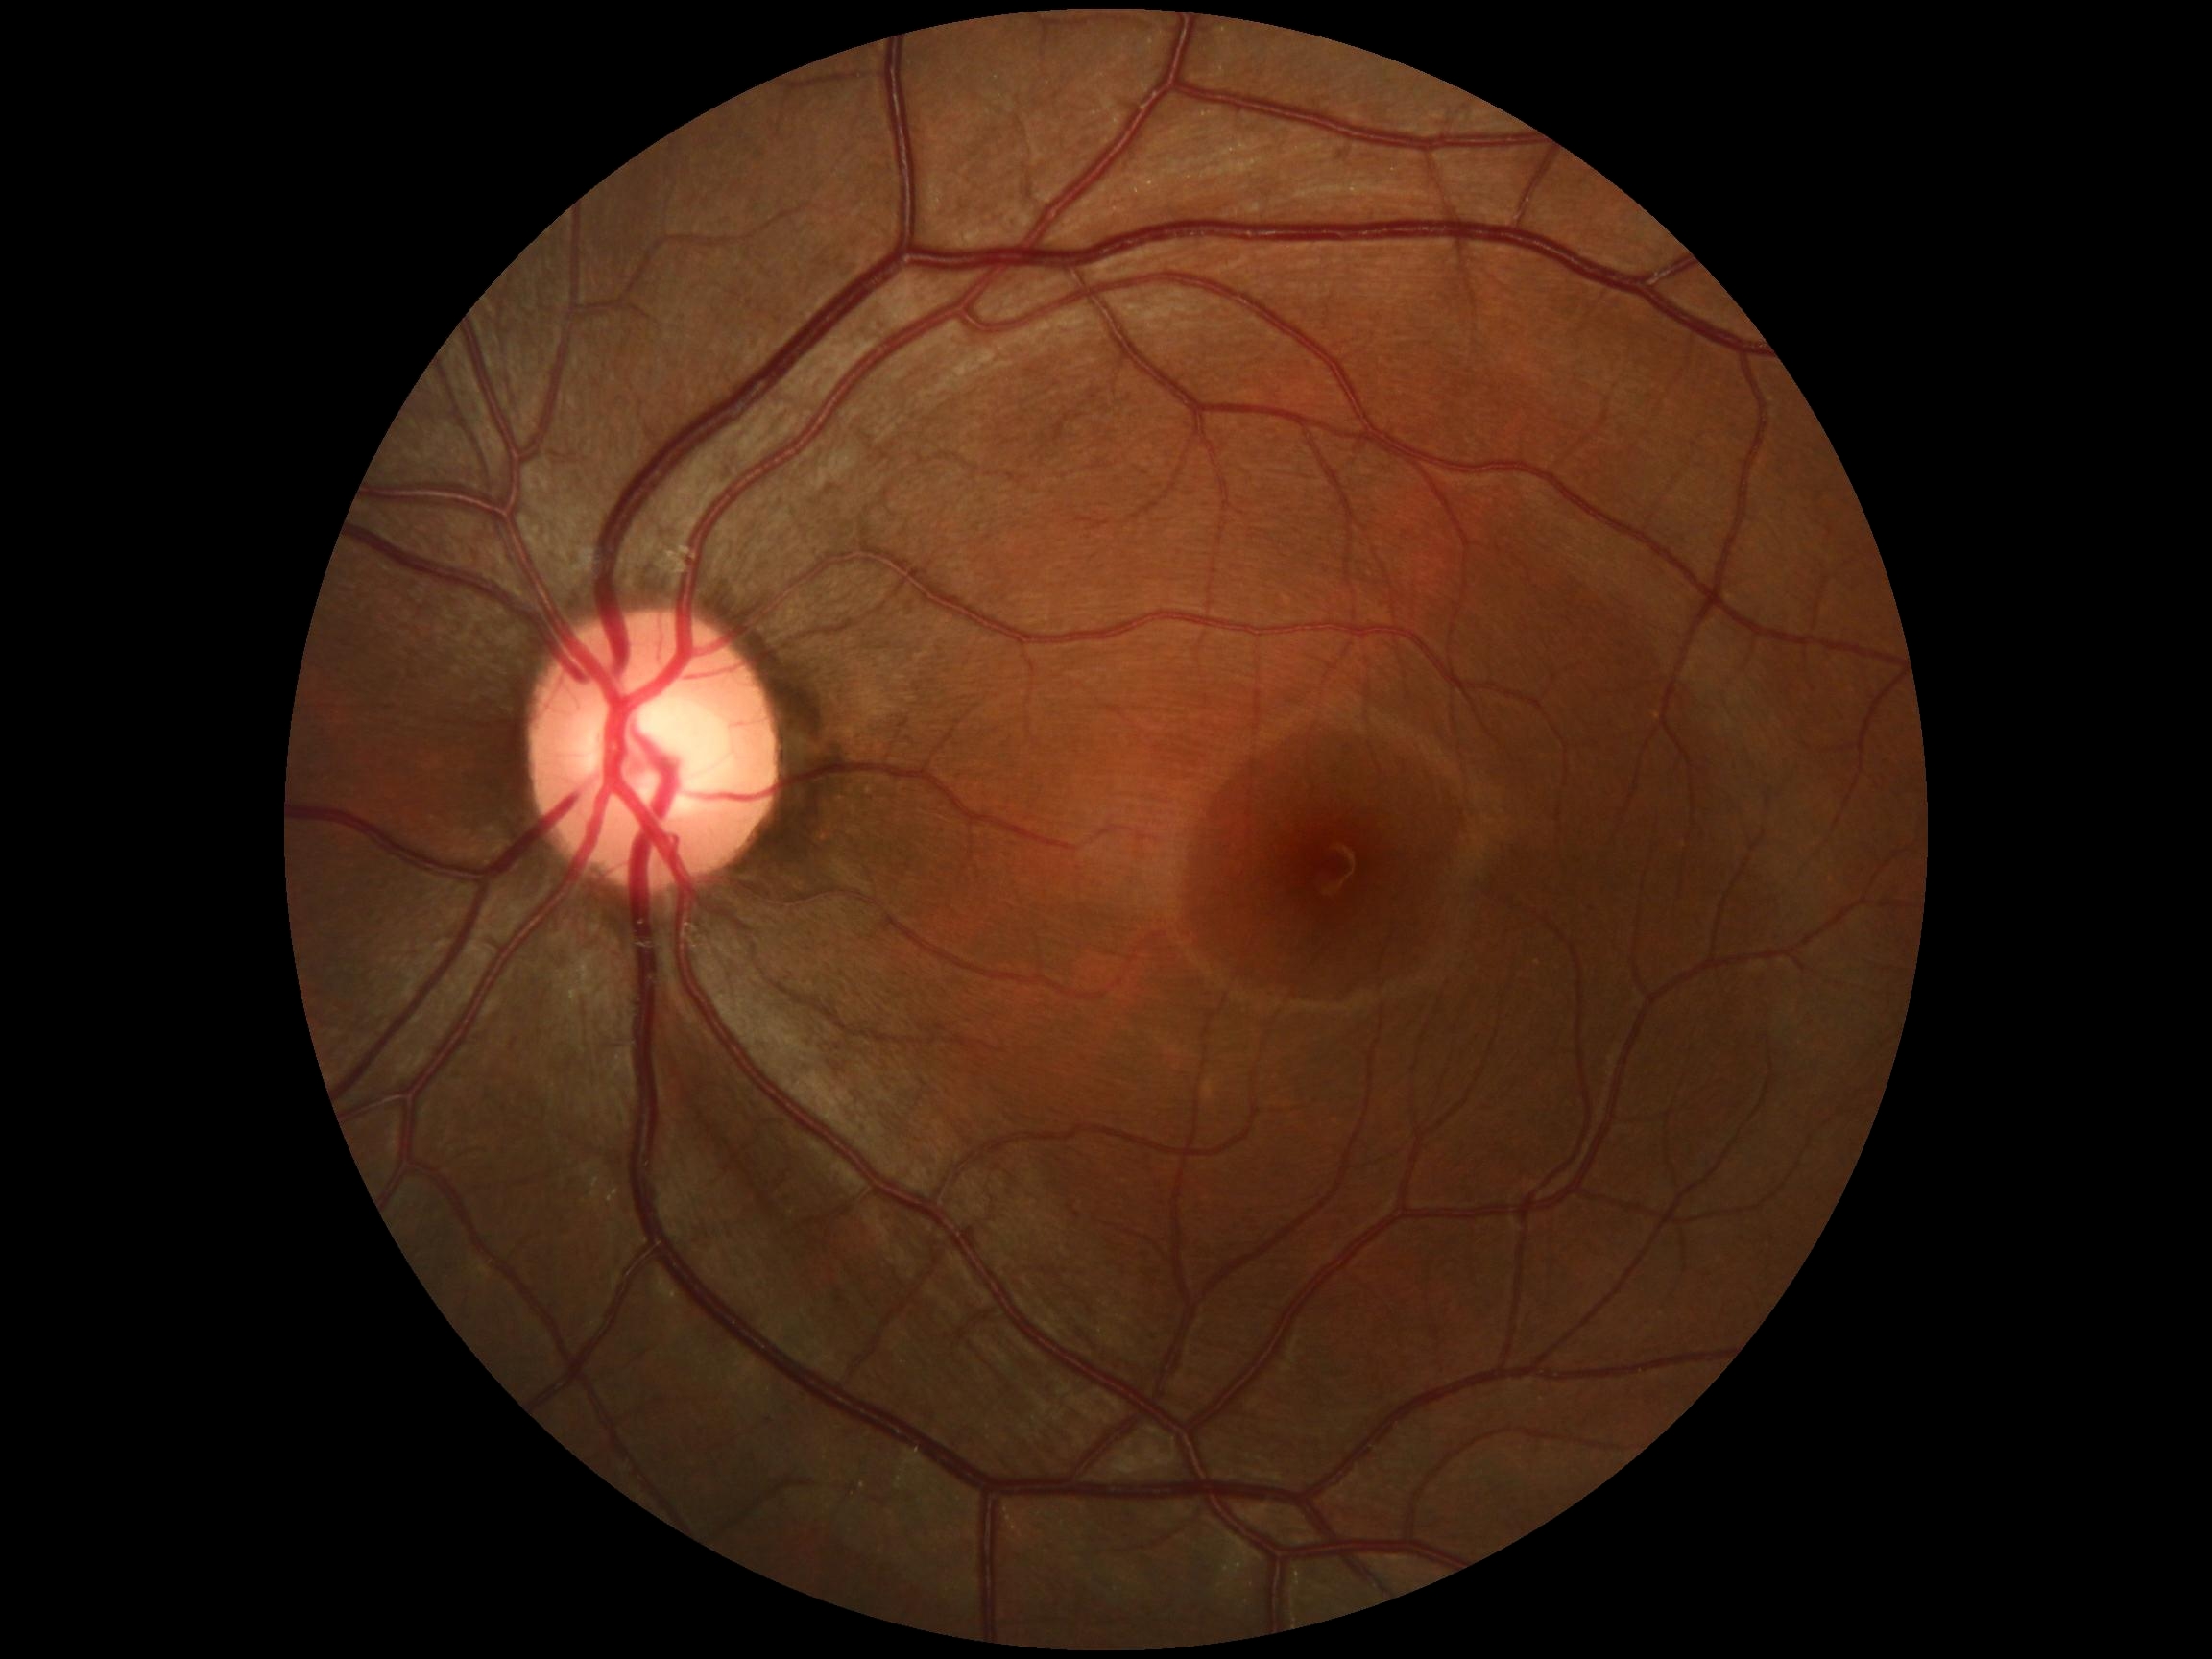 No diabetic retinal disease findings. DR severity: no apparent retinopathy (grade 0).